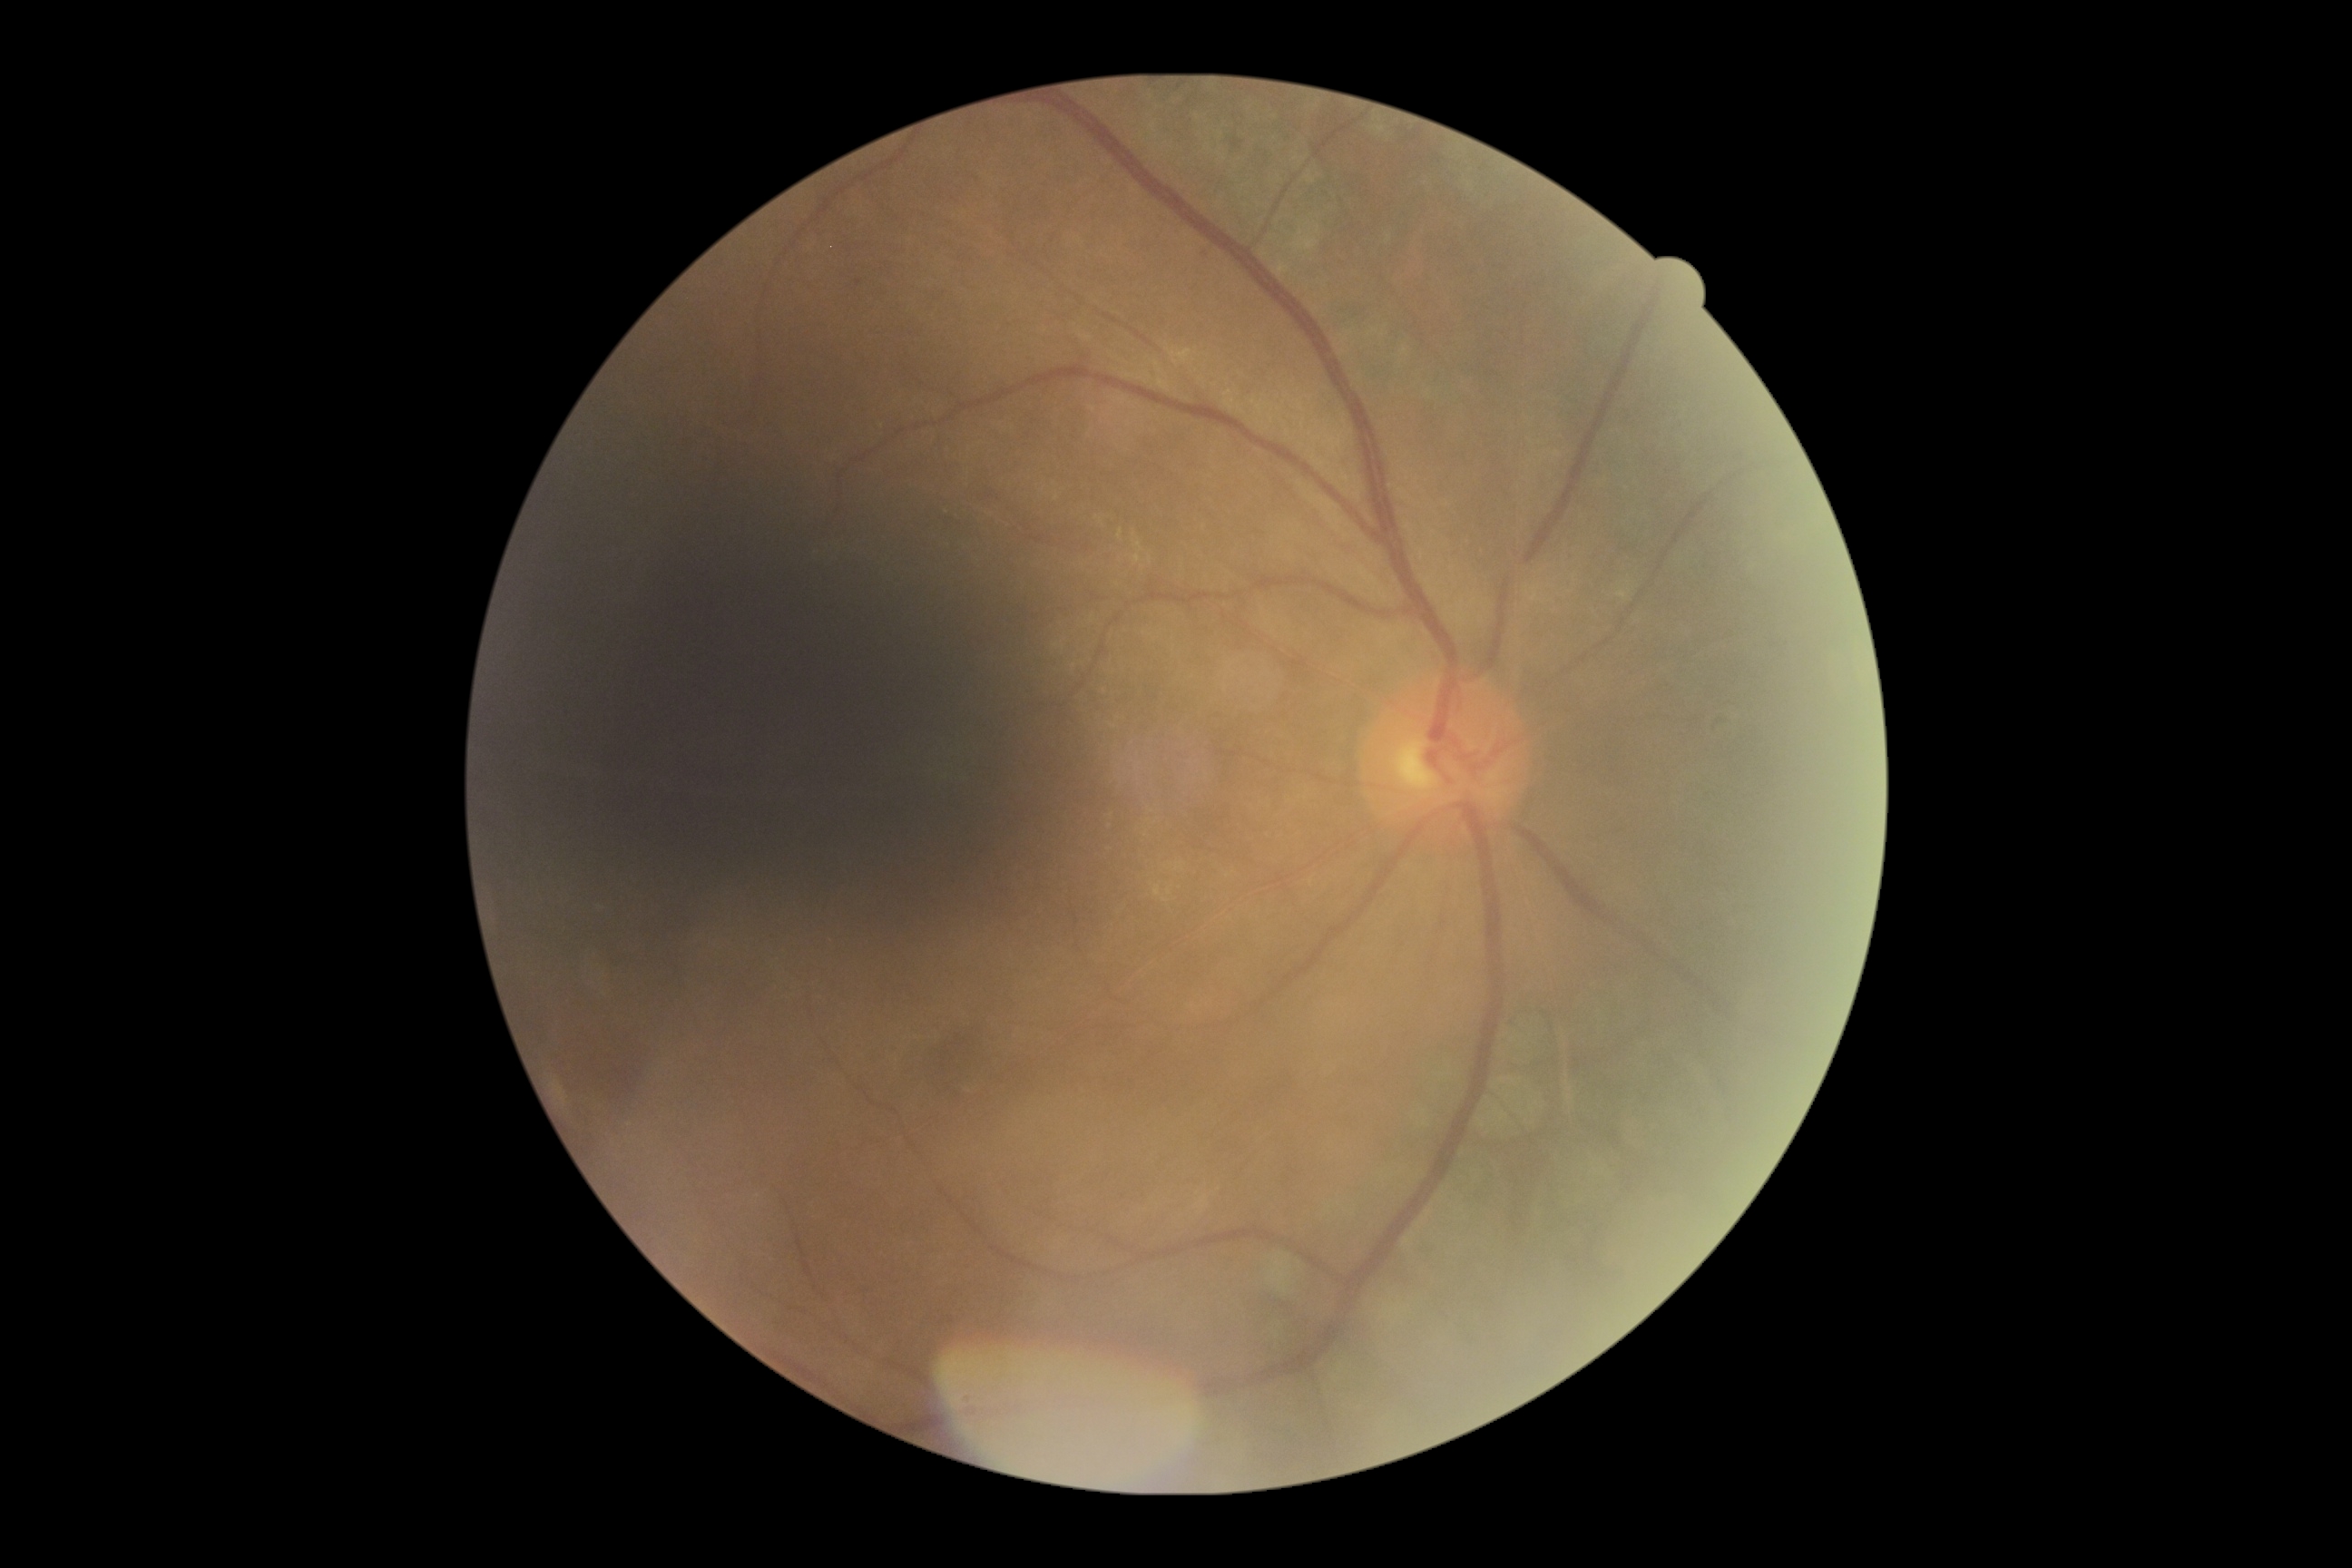

Diabetic retinopathy: grade 1 (mild NPDR).